848 by 848 pixels.
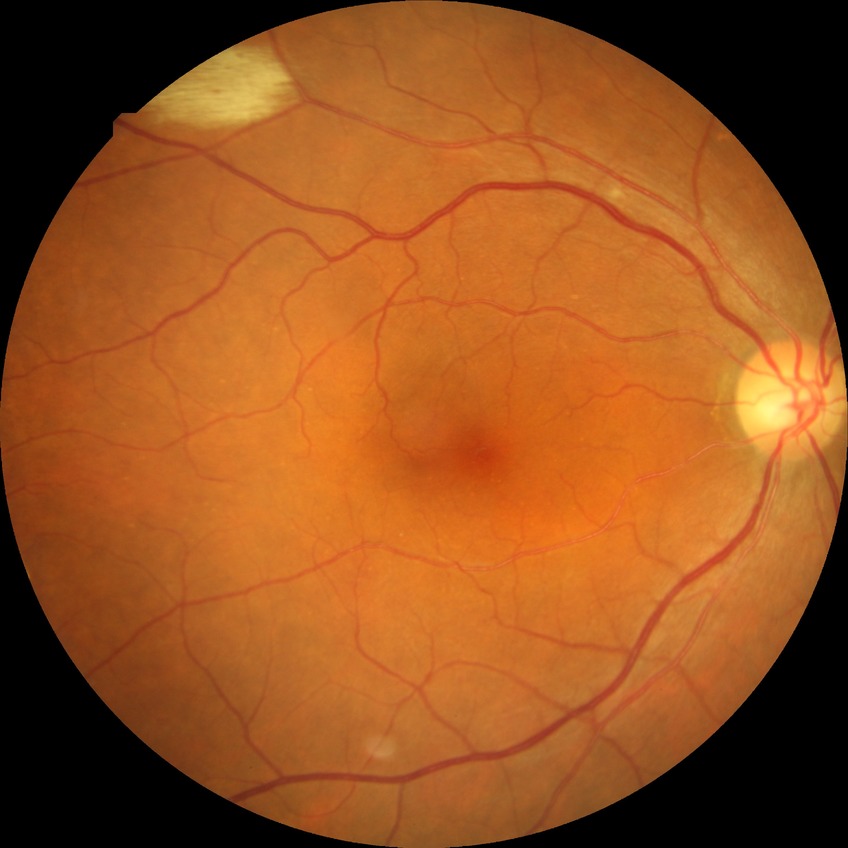 diabetic retinopathy (DR): no diabetic retinopathy (NDR).